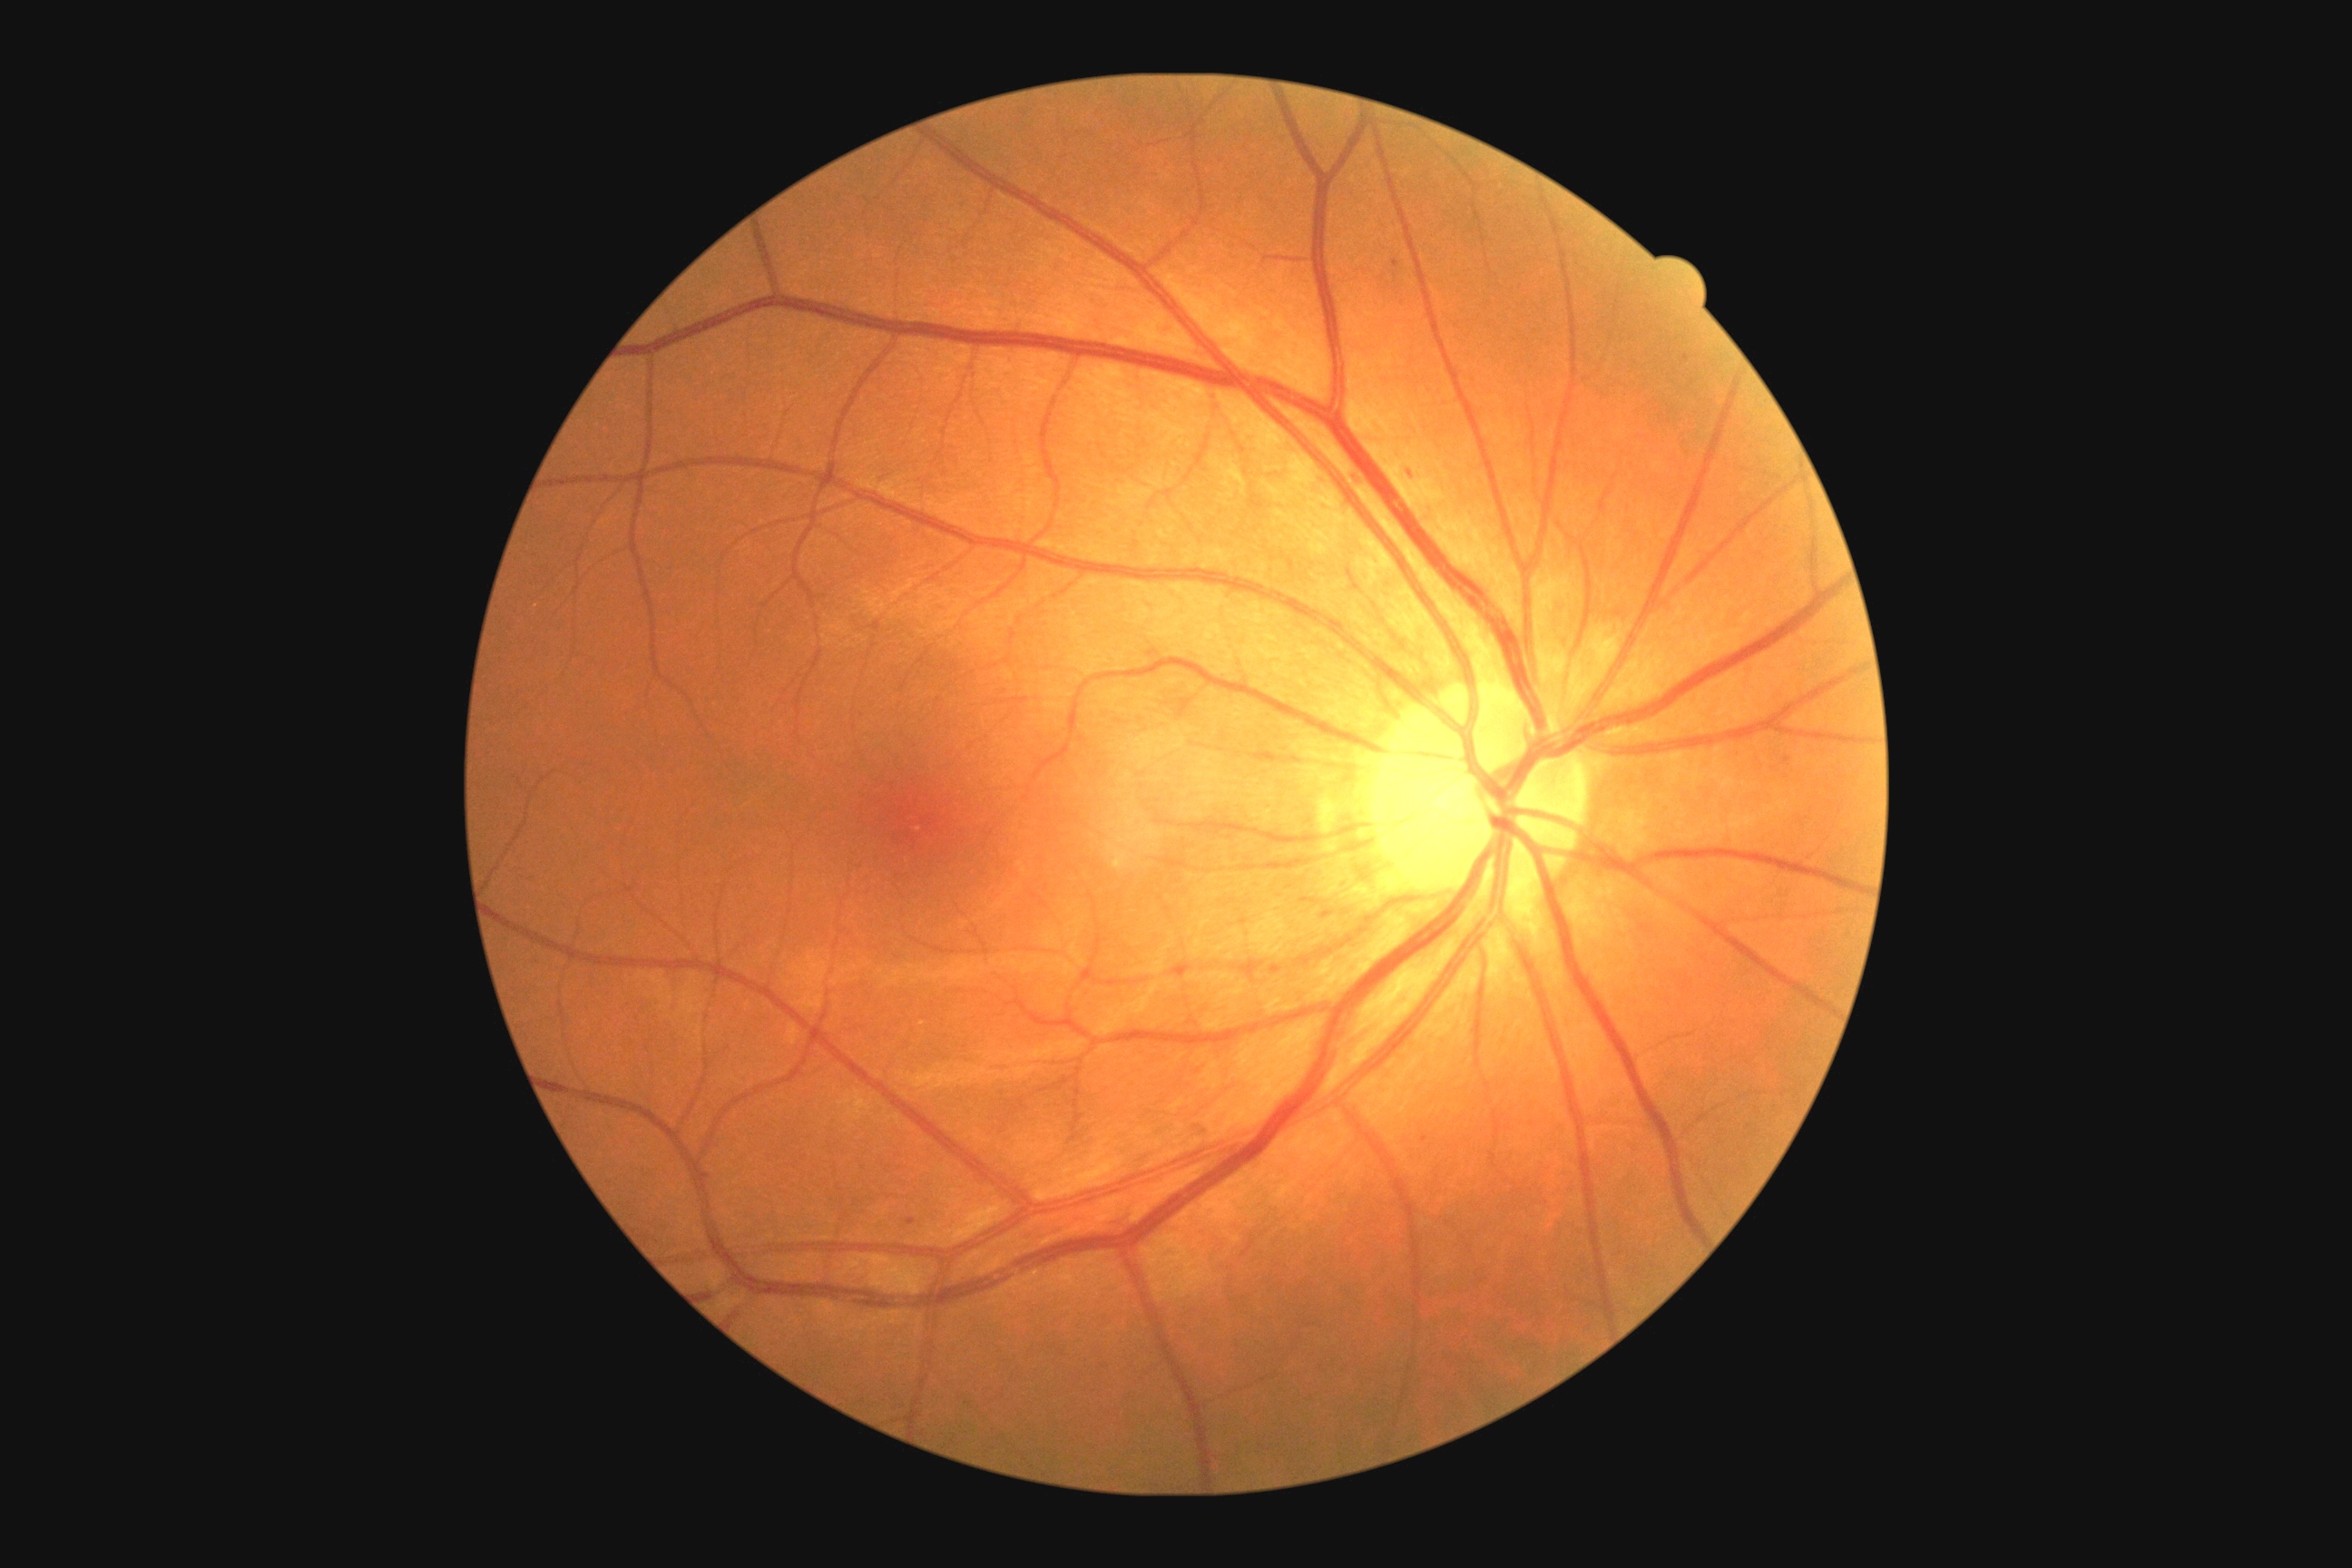
dr_category: non-proliferative diabetic retinopathy
dr_grade: mild non-proliferative diabetic retinopathy (grade 1)